Infant wide-field fundus photograph · 640 by 480 pixels — 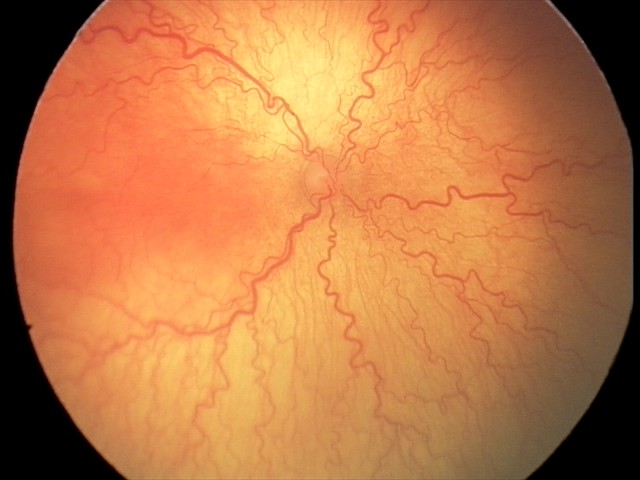 Screening examination consistent with aggressive retinopathy of prematurity (A-ROP).